Acquired with a Topcon TRC-50DX.
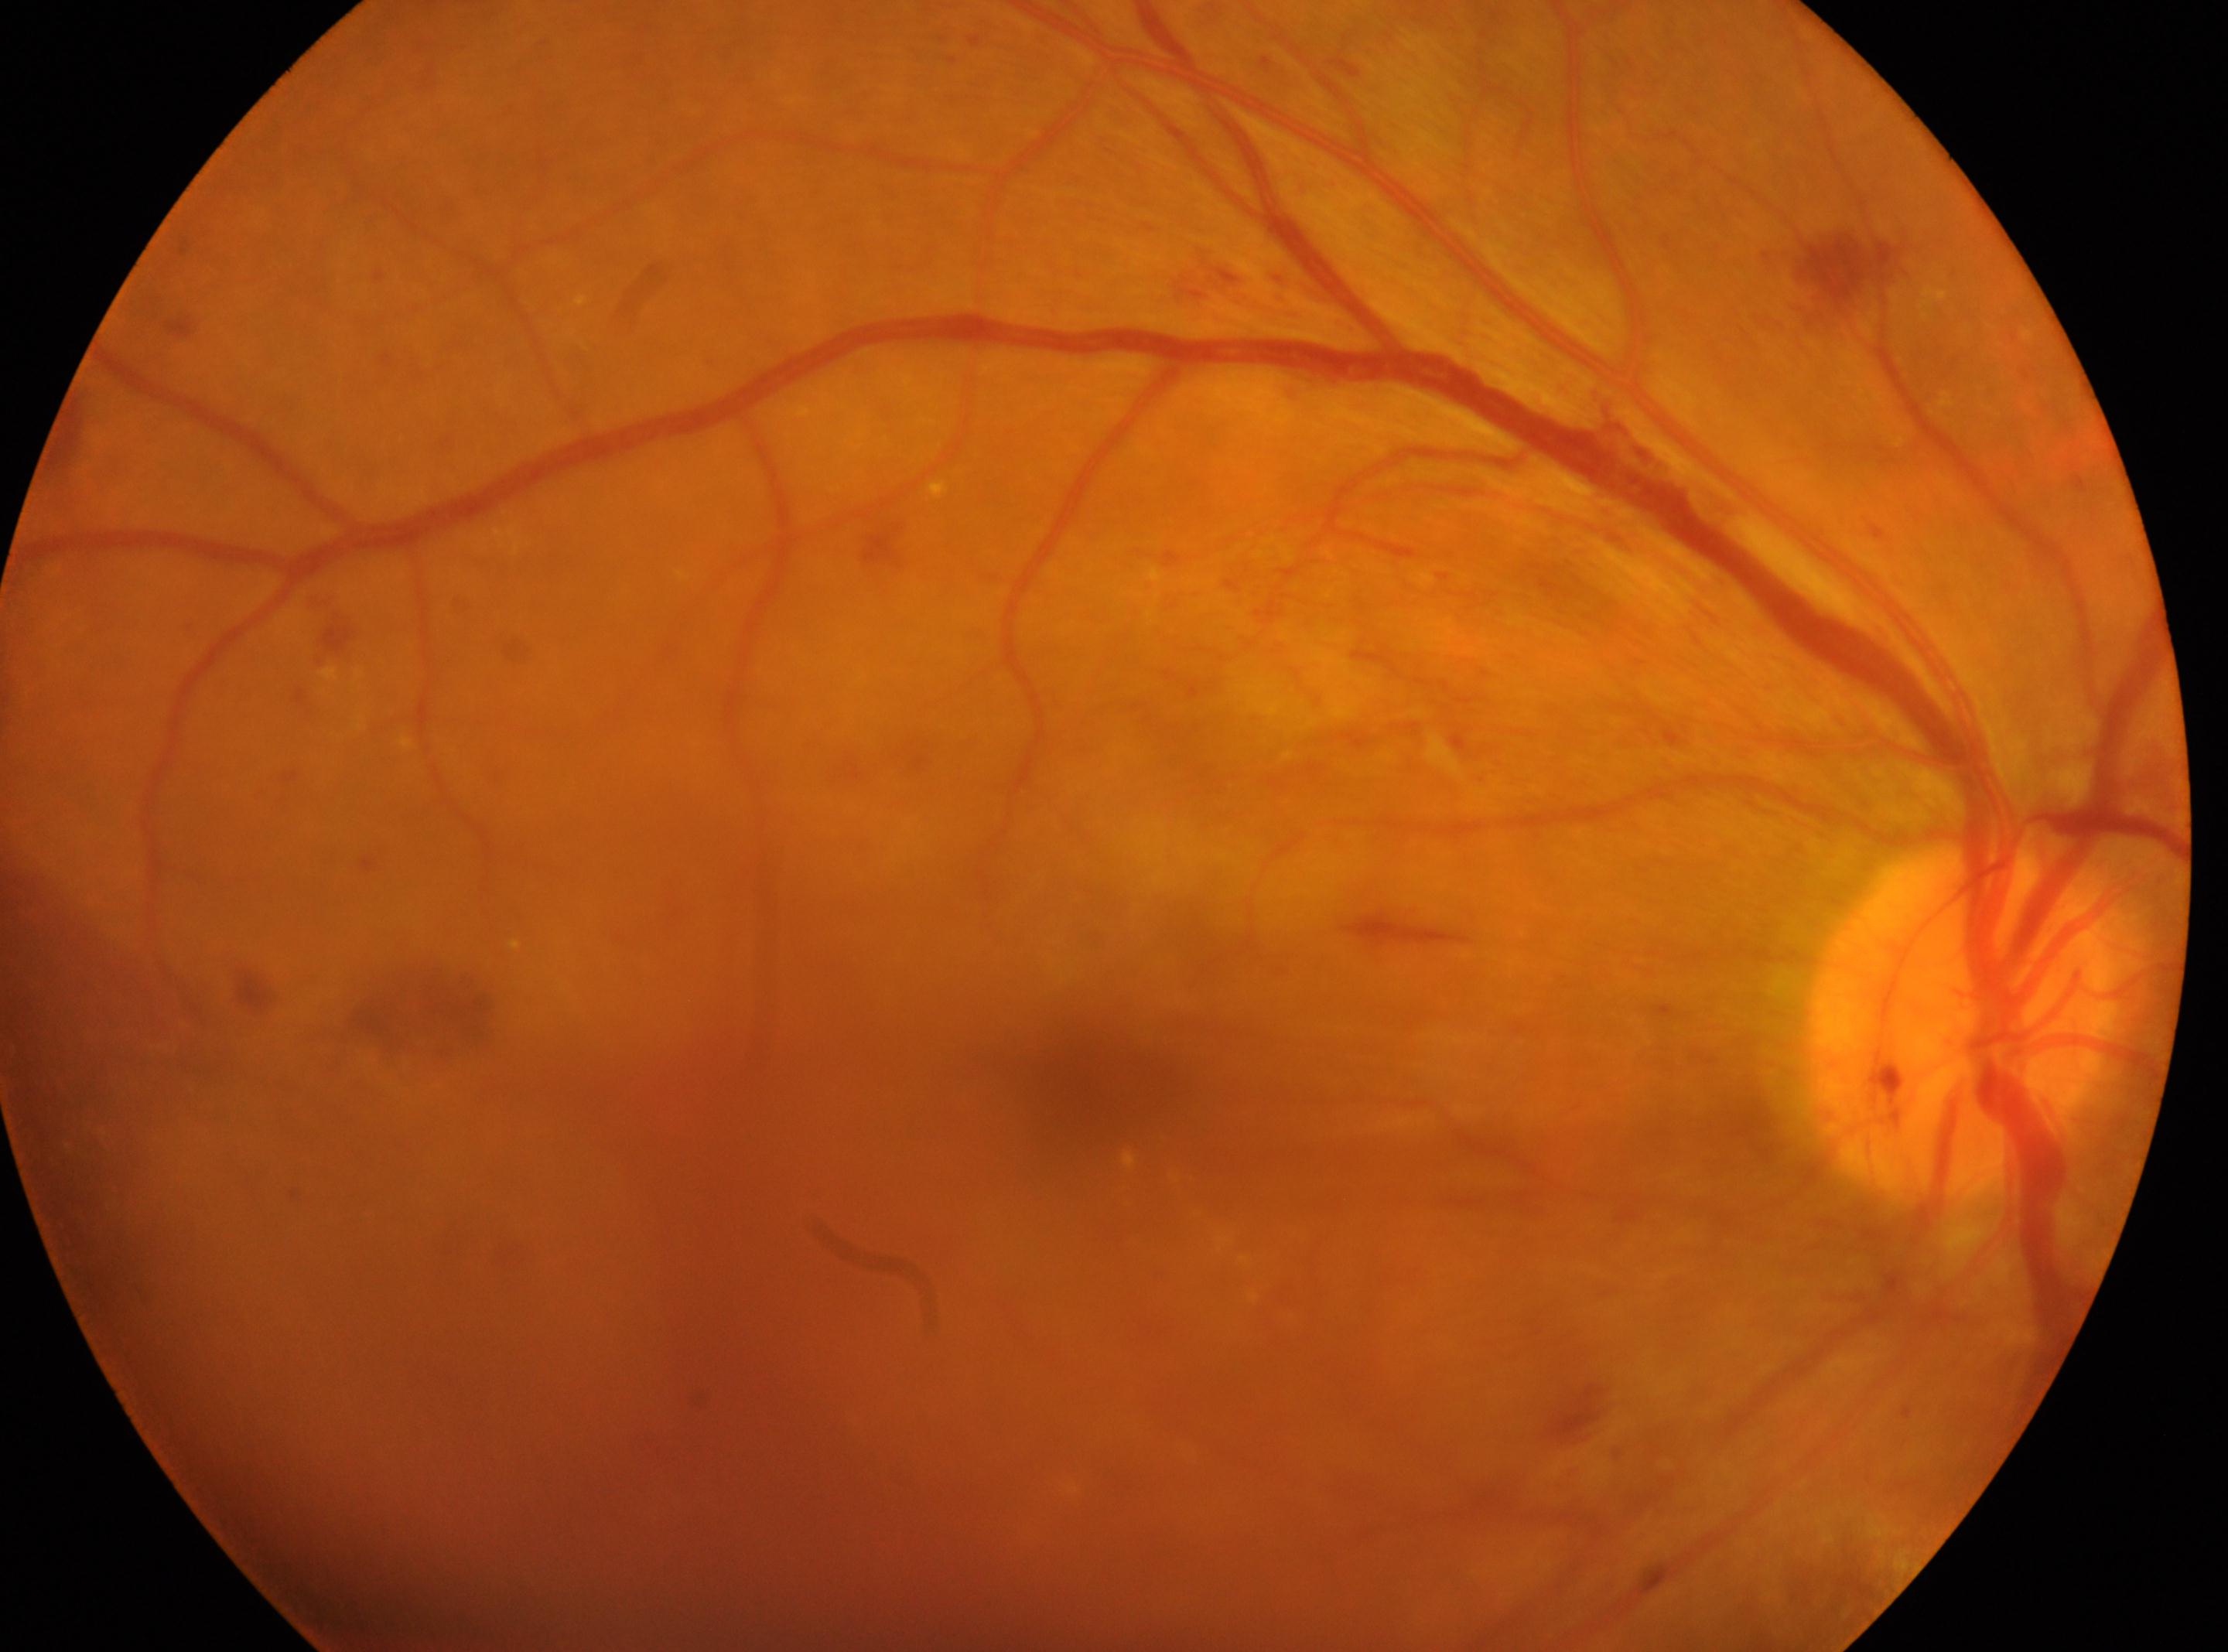 Fovea: (x=1088, y=1083).
Eye: oculus dexter.
ONH: (x=1960, y=1022).
DR stage is grade 4.